Acquired with a NIDEK AFC-230. 848 by 848 pixels. 45° FOV:
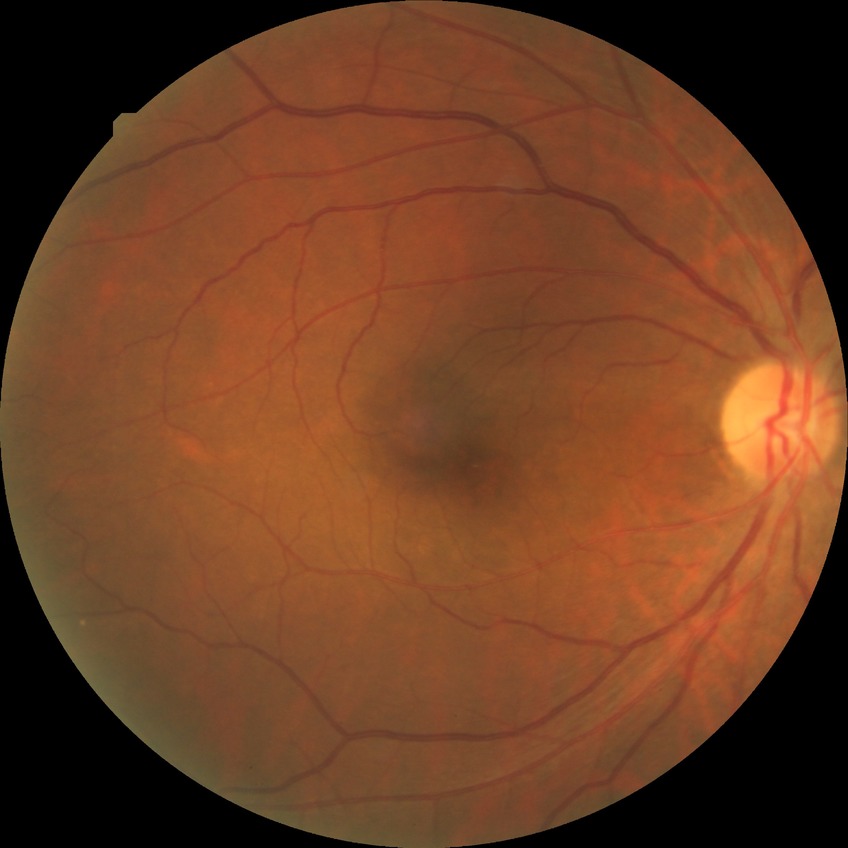 DR stage is NDR.